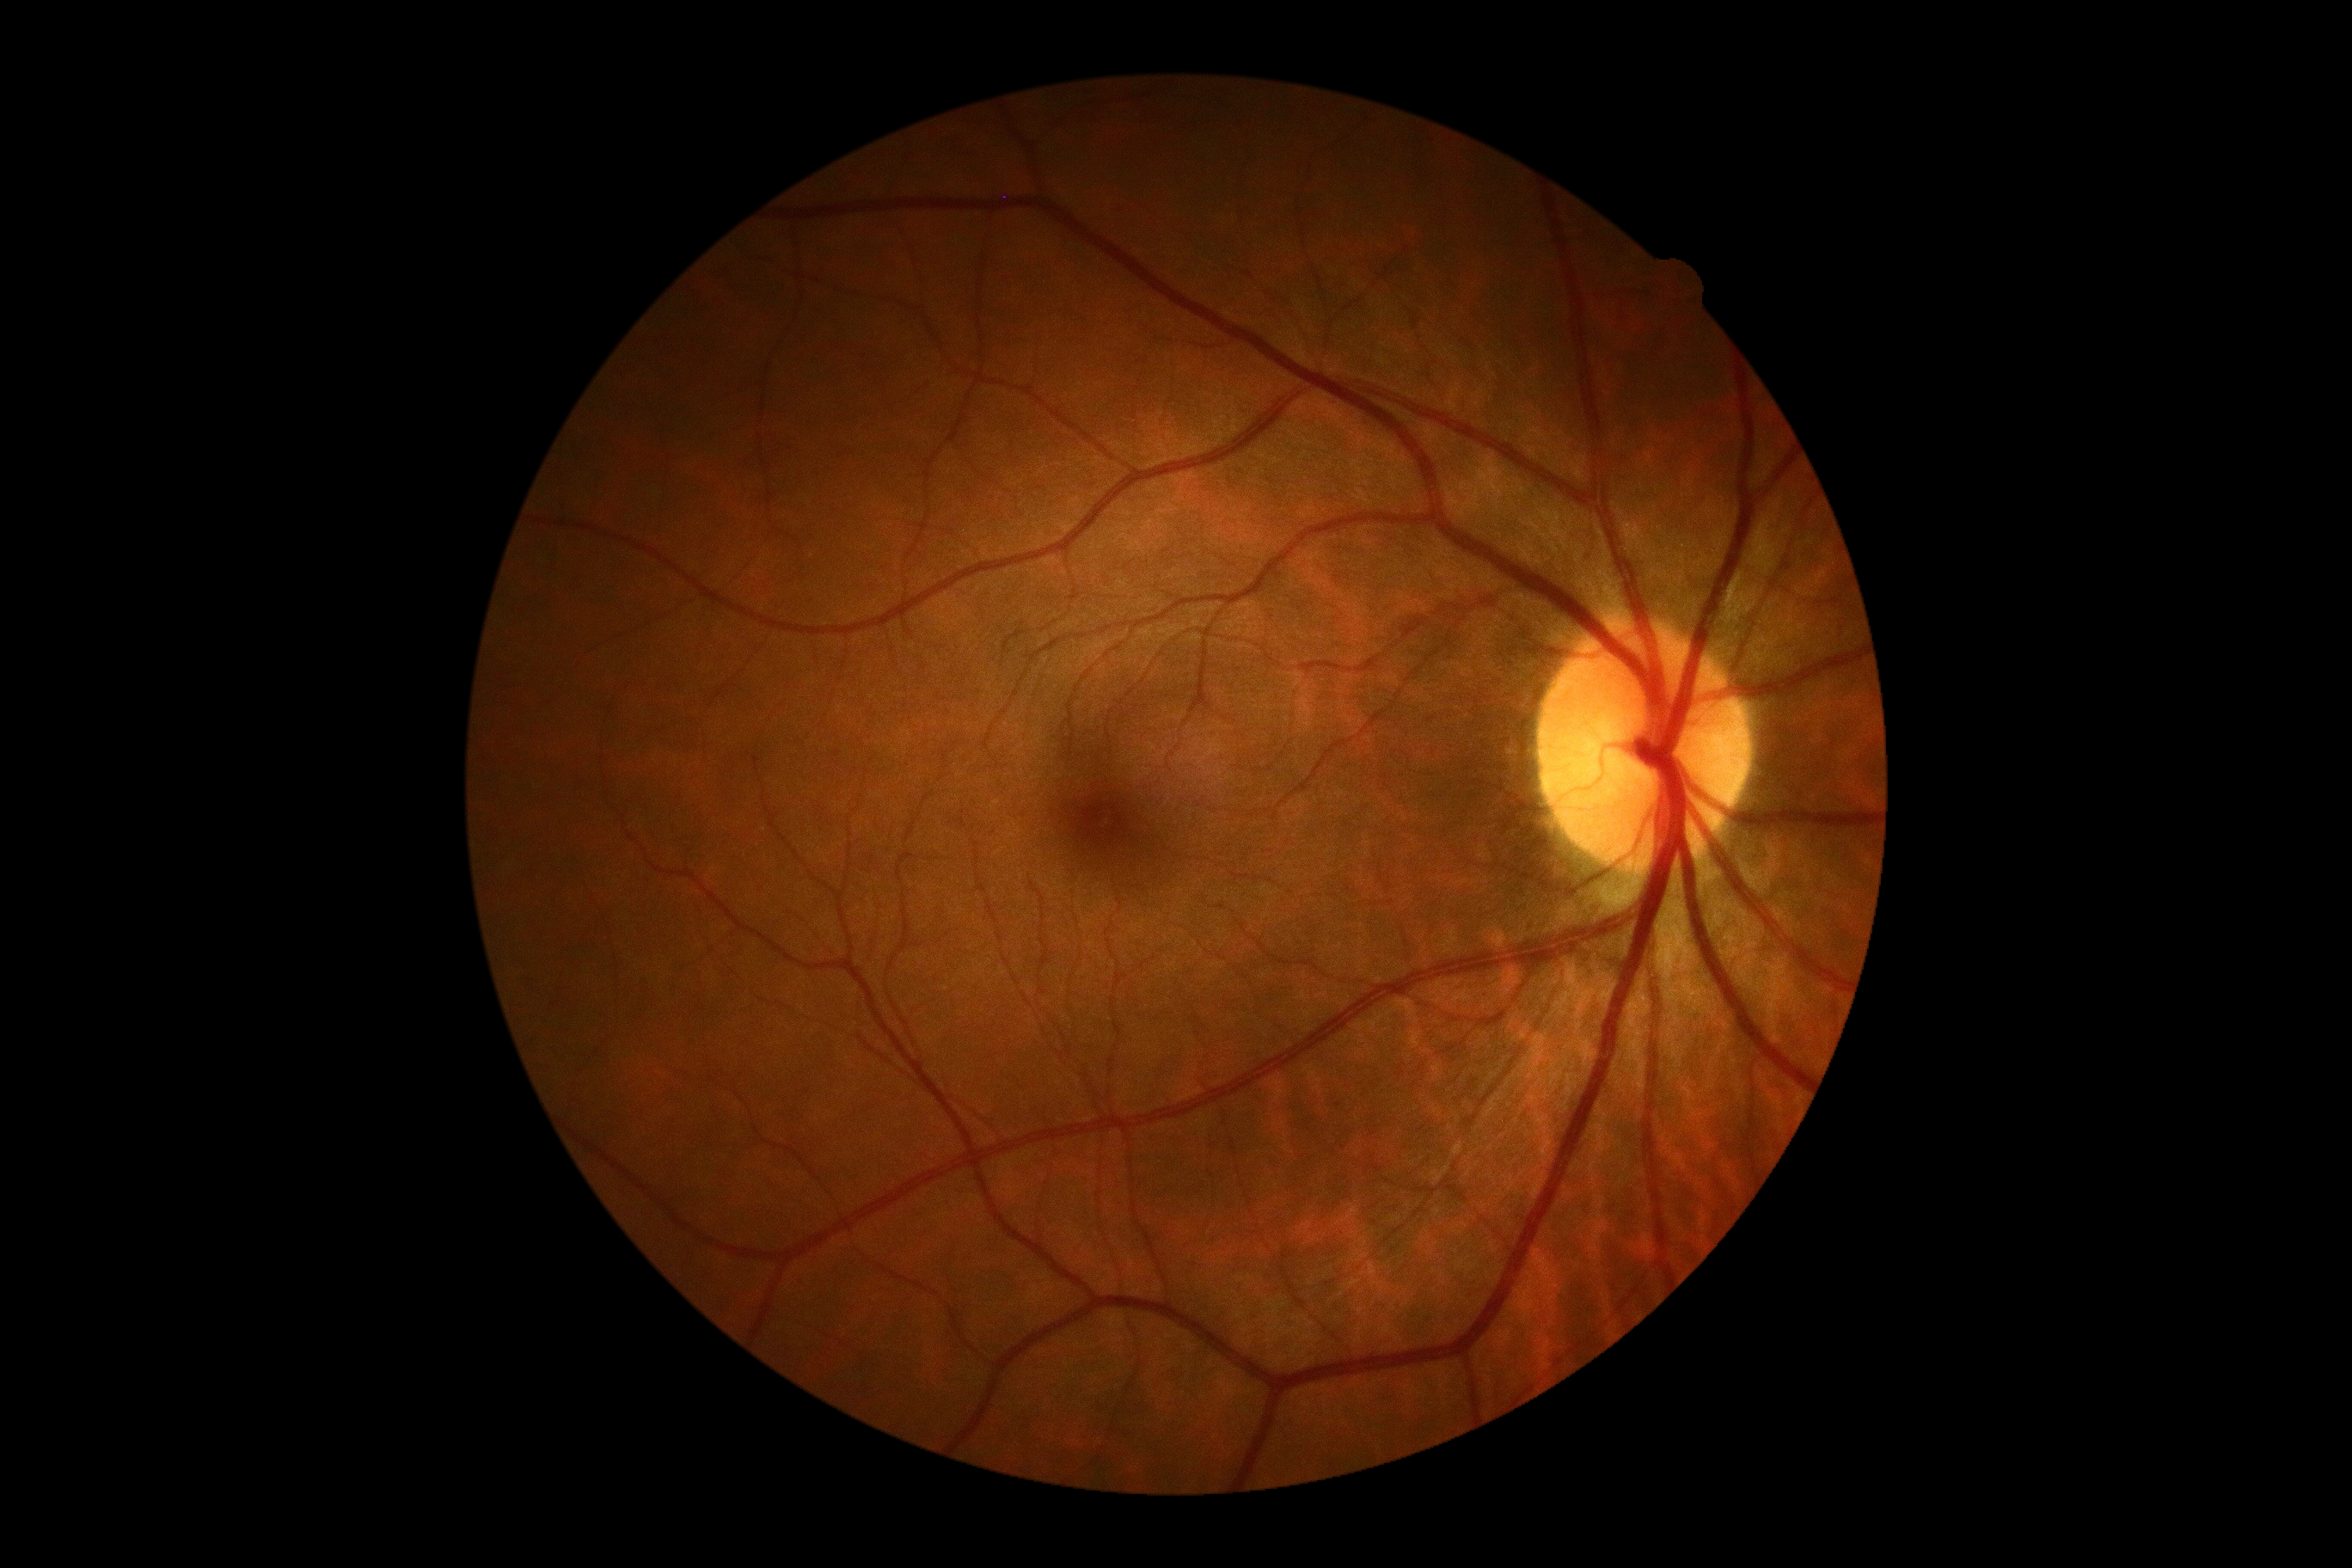 {"dr_grade": "grade 0", "dr_impression": "negative for DR"}